Diabetic retinopathy graded by the modified Davis classification · retinal fundus photograph: 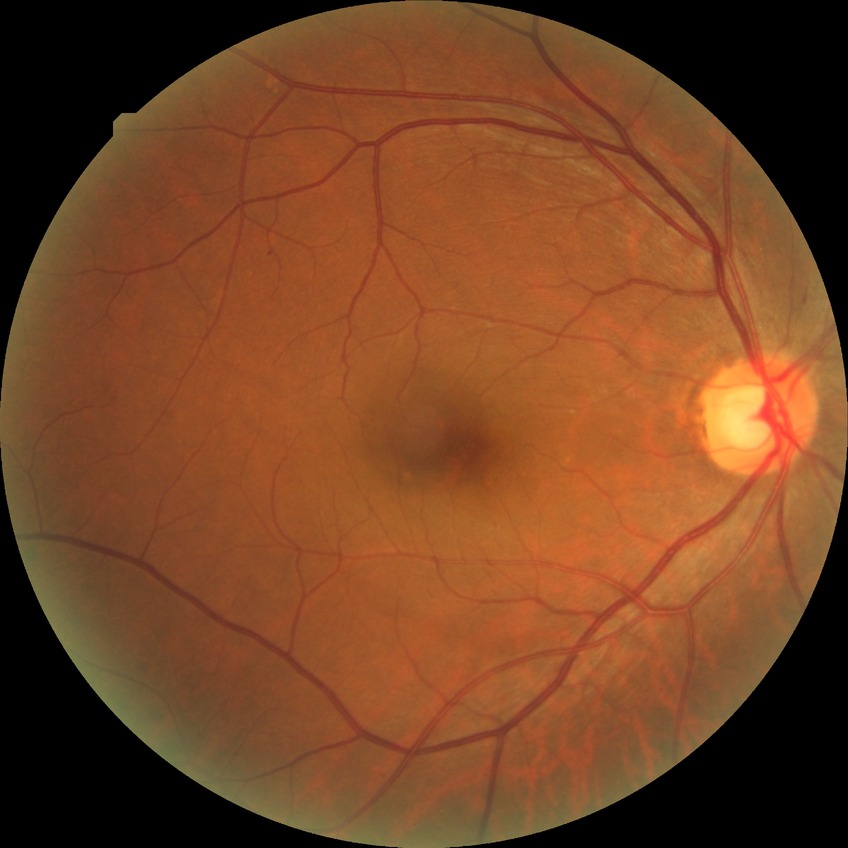   davis_grade: SDR (simple diabetic retinopathy)